Wide-field fundus photograph of an infant: 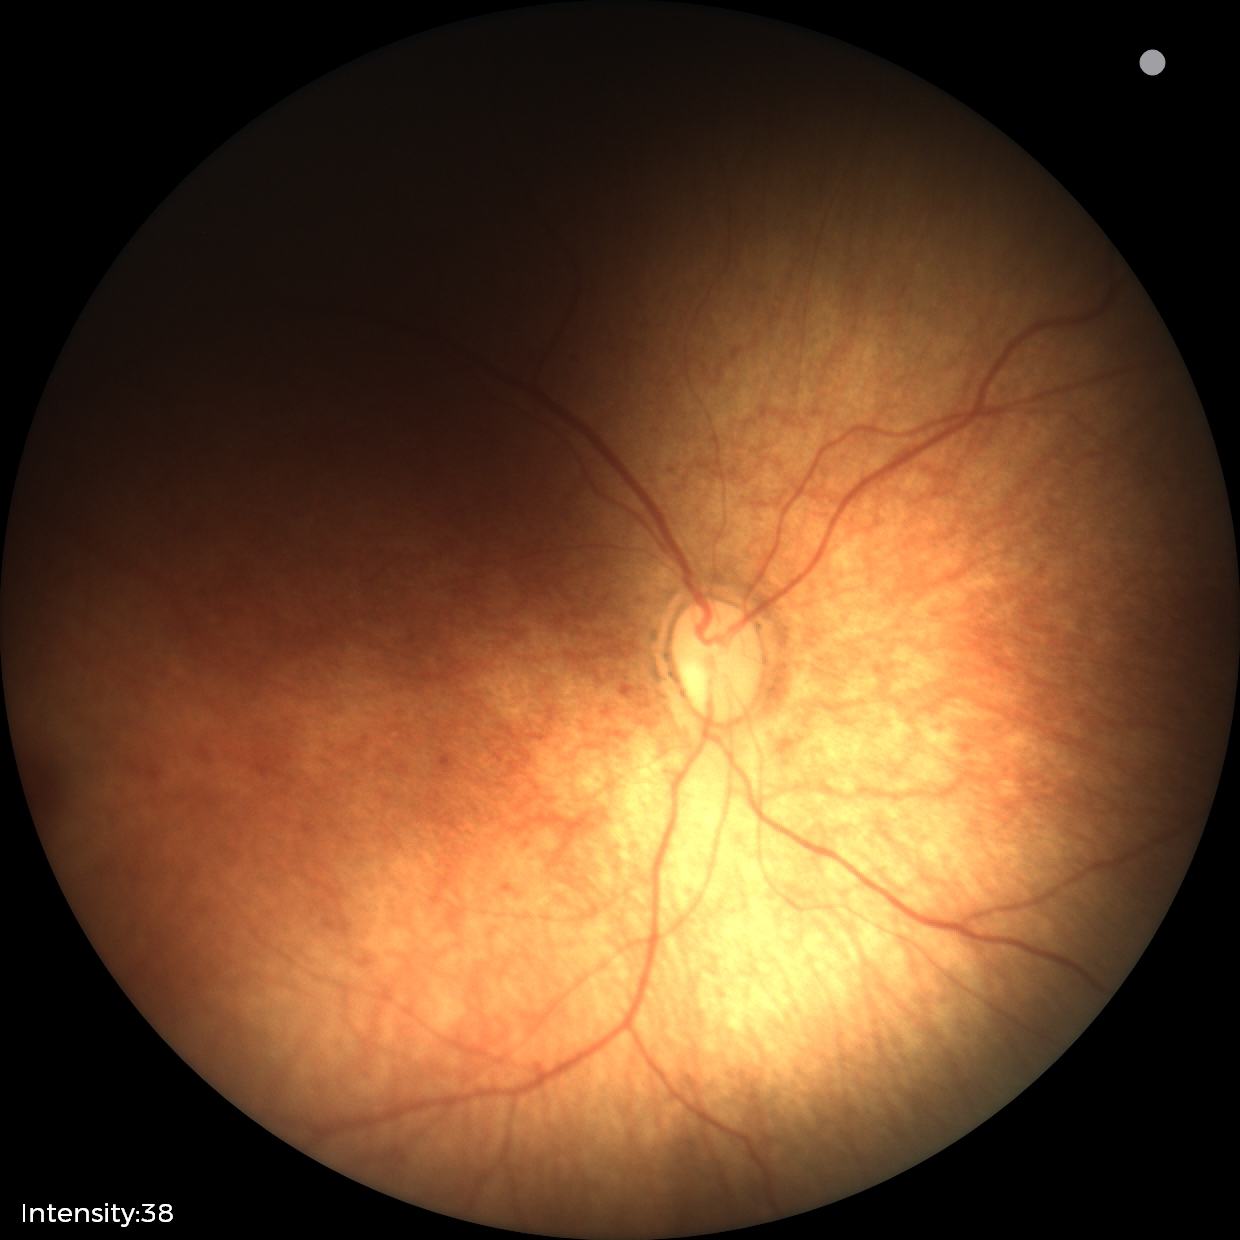 Impression = normal retinal appearance.